Camera: NIDEK AFC-230 · diabetic retinopathy graded by the modified Davis classification.
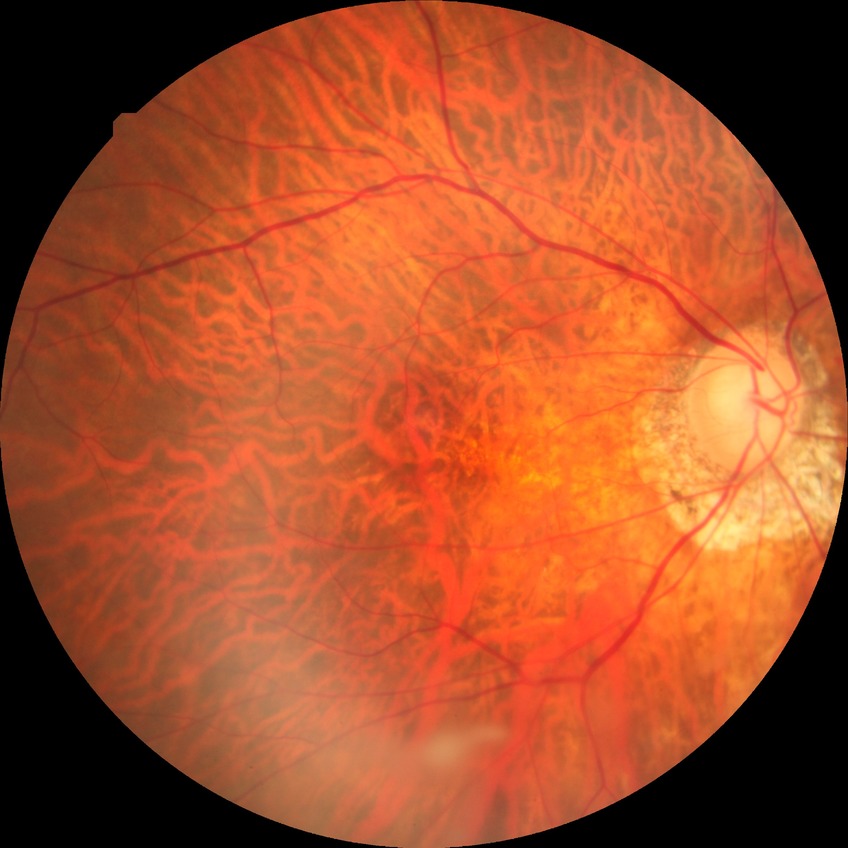

Assessment:
• diabetic retinopathy (DR) — simple diabetic retinopathy (SDR)
• DR class — non-proliferative diabetic retinopathy